Captured on a Kowa VX-10α fundus camera; 2361x1568px; pupil-dilated; macula-centered field; FOV: 50 degrees; color fundus image:
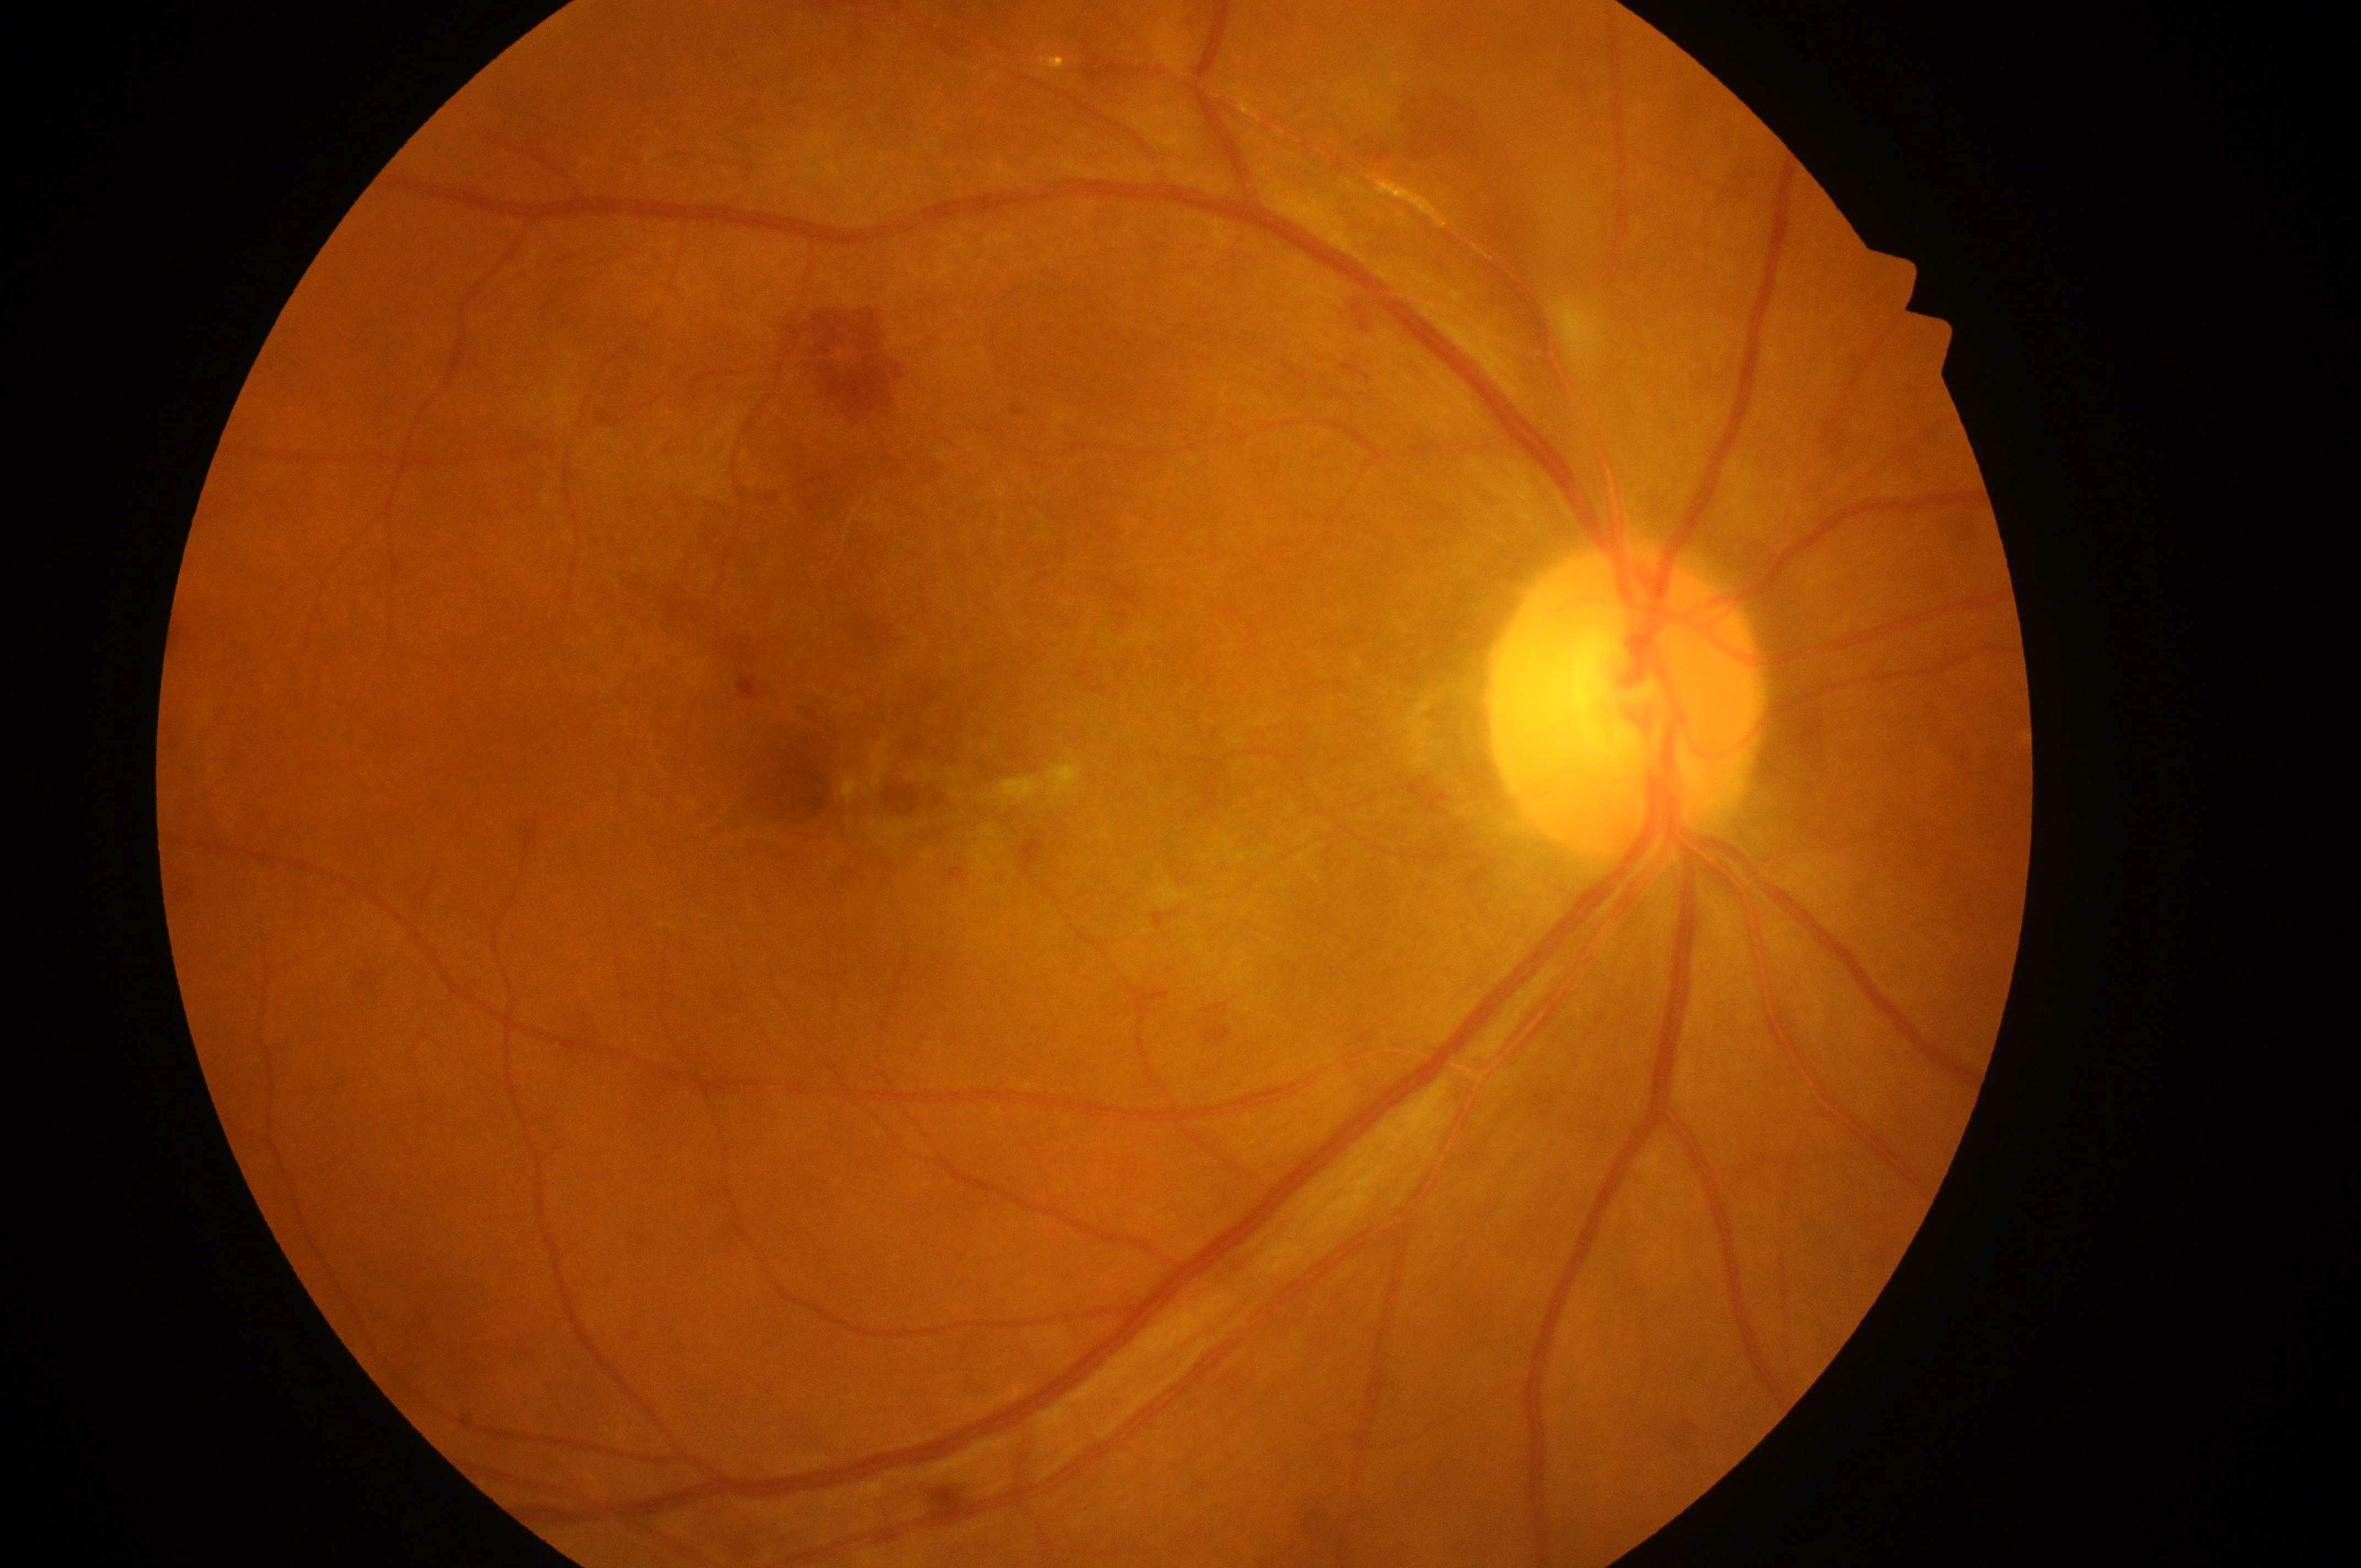

eye: OD
dme_grade: 0/2
dr_grade: 3/4
fovea: (x=847, y=800)
optic_disc: (x=1619, y=707)